Camera: Clarity RetCam 3 (130° FOV); 640x480px; wide-field fundus photograph of an infant
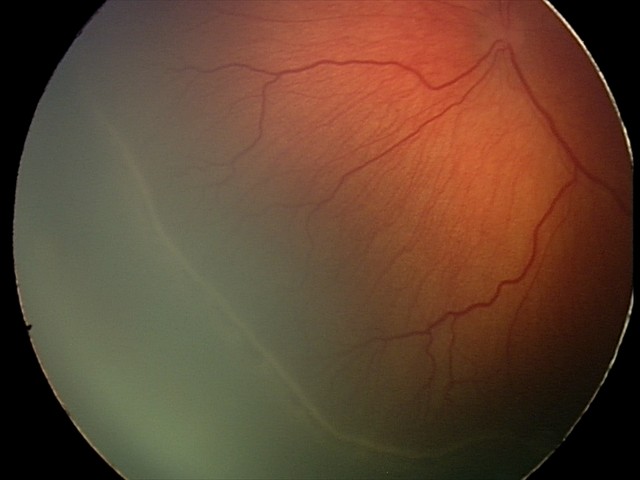 Screening: no plus disease — posterior pole vessels without abnormal dilation or tortuosity | retinopathy of prematurity (ROP) stage 2.